Color fundus image. Camera: NIDEK AFC-230. Without pupil dilation — 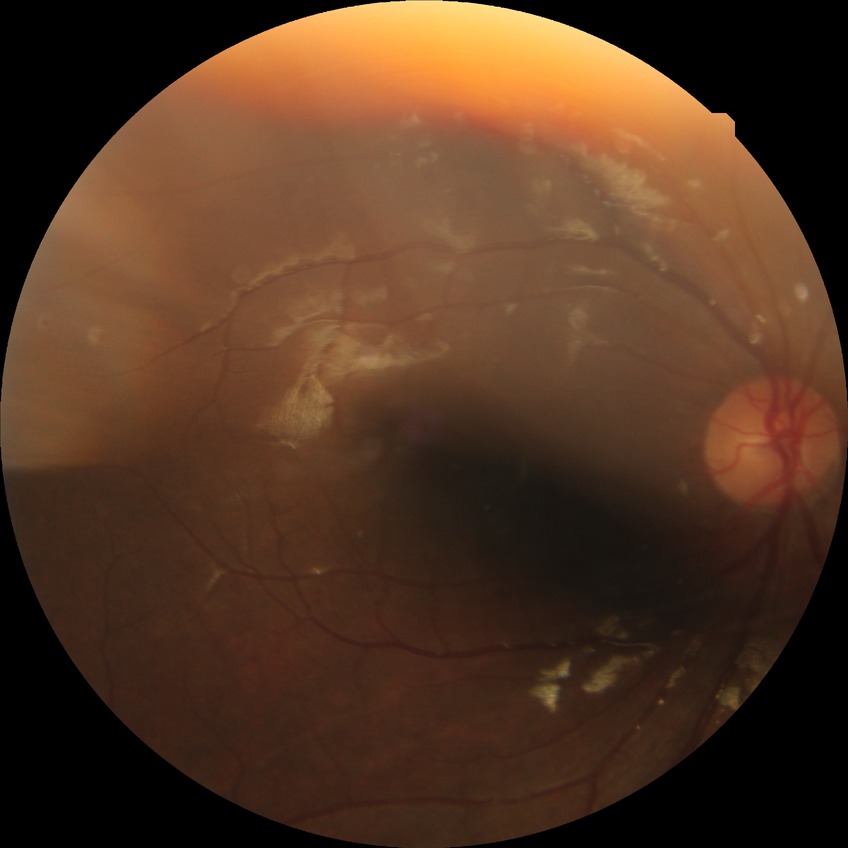

Diabetic retinopathy grade: no diabetic retinopathy.